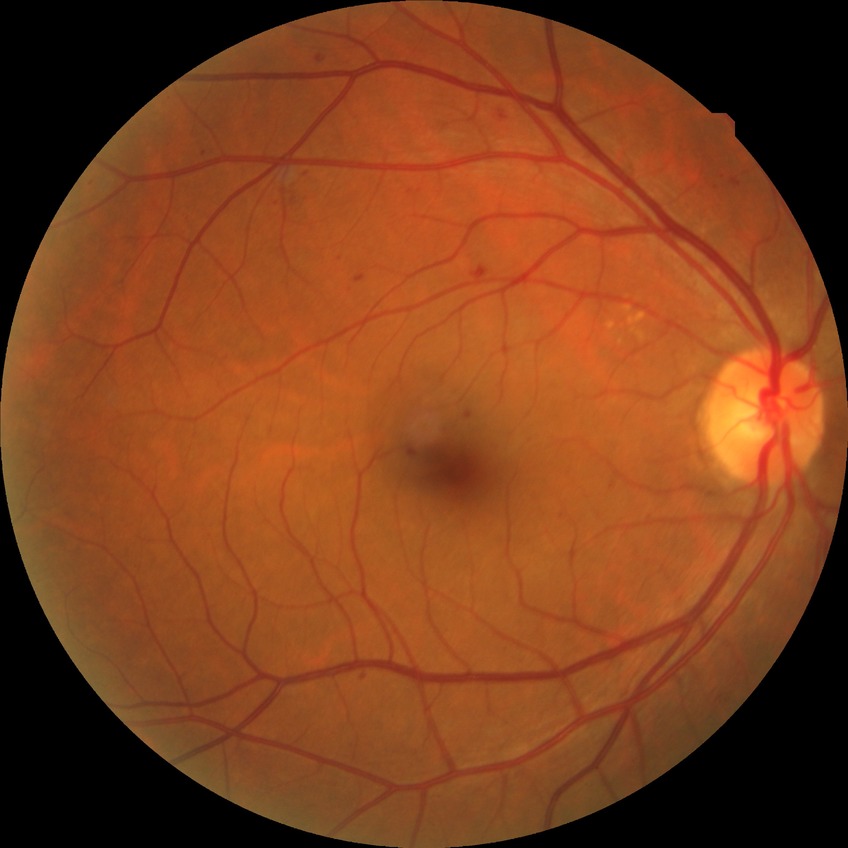

{"proliferative_class": "non-proliferative diabetic retinopathy", "davis_grade": "SDR"}